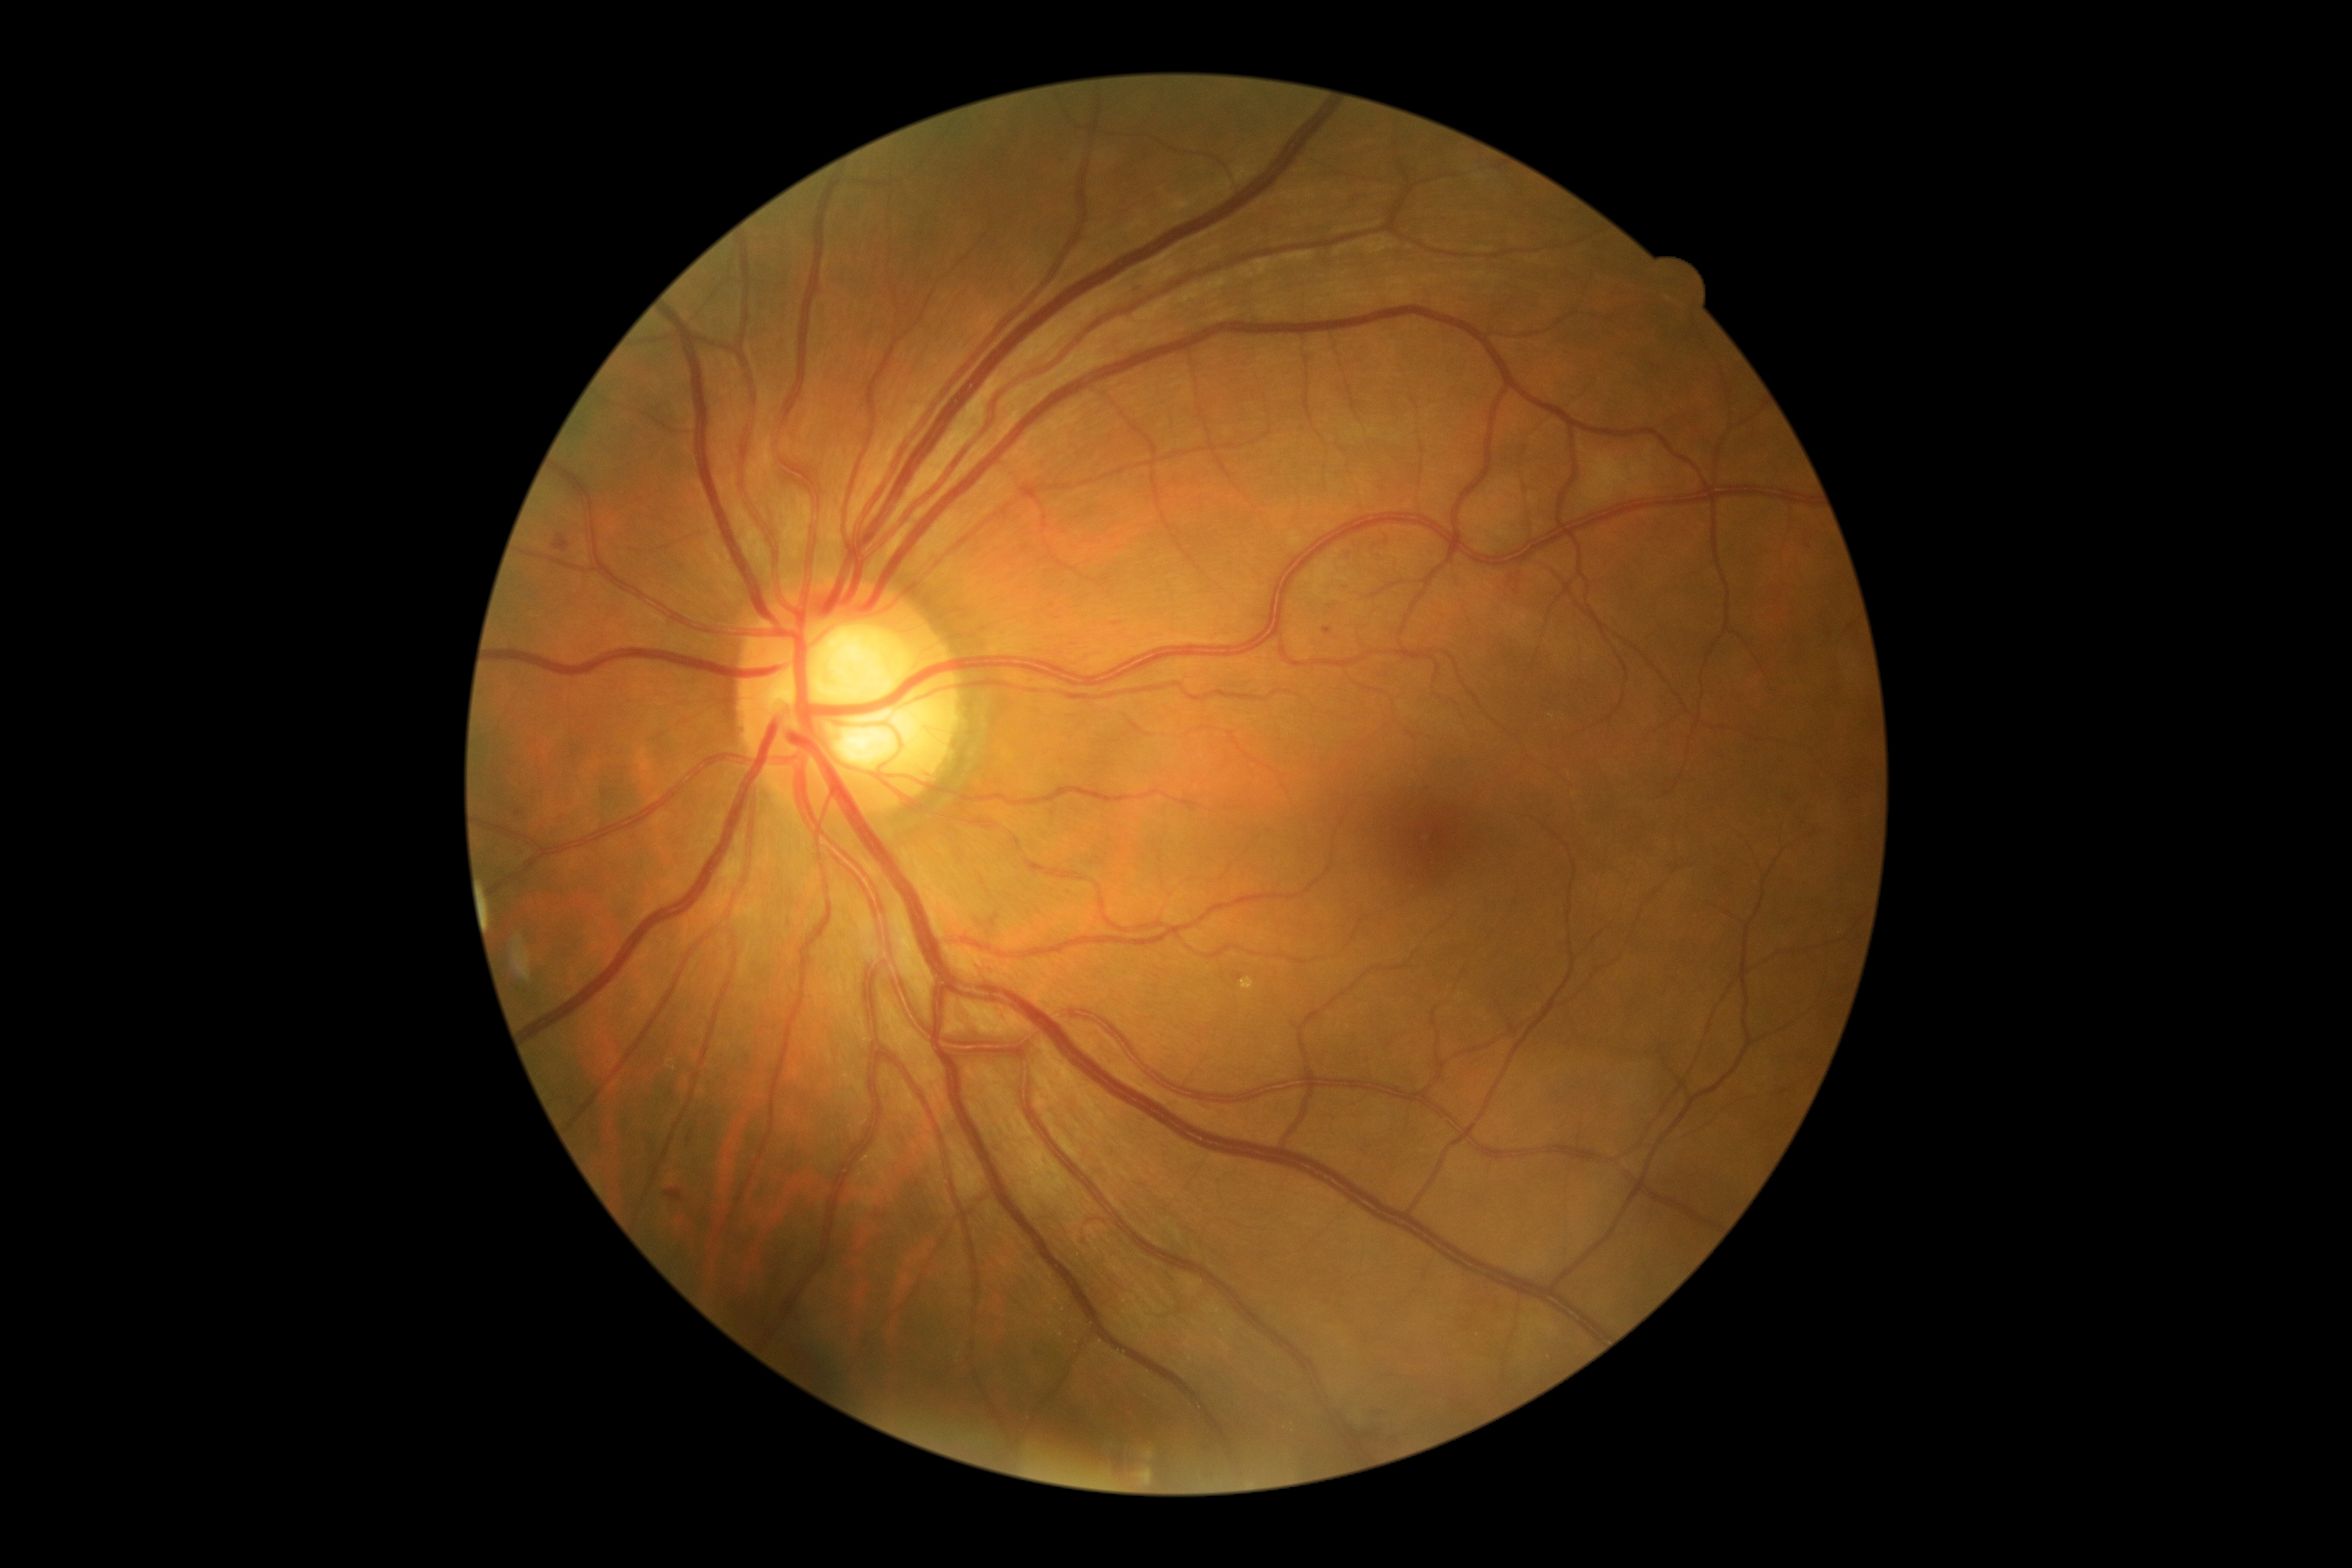 Diabetic retinopathy (DR) is 2
A subset of detected lesions:
- soft exudates (SEs): not present
- hard exudates (EXs): not present
- hemorrhages (HEs): Rect(689, 1129, 695, 1149) | Rect(665, 1189, 683, 1203) | Rect(553, 536, 570, 553)
- microaneurysms (MAs) (more not shown): Rect(1323, 628, 1333, 635) | Rect(1234, 972, 1244, 983)
- Additional small MAs near 518, 814 | 1137, 293